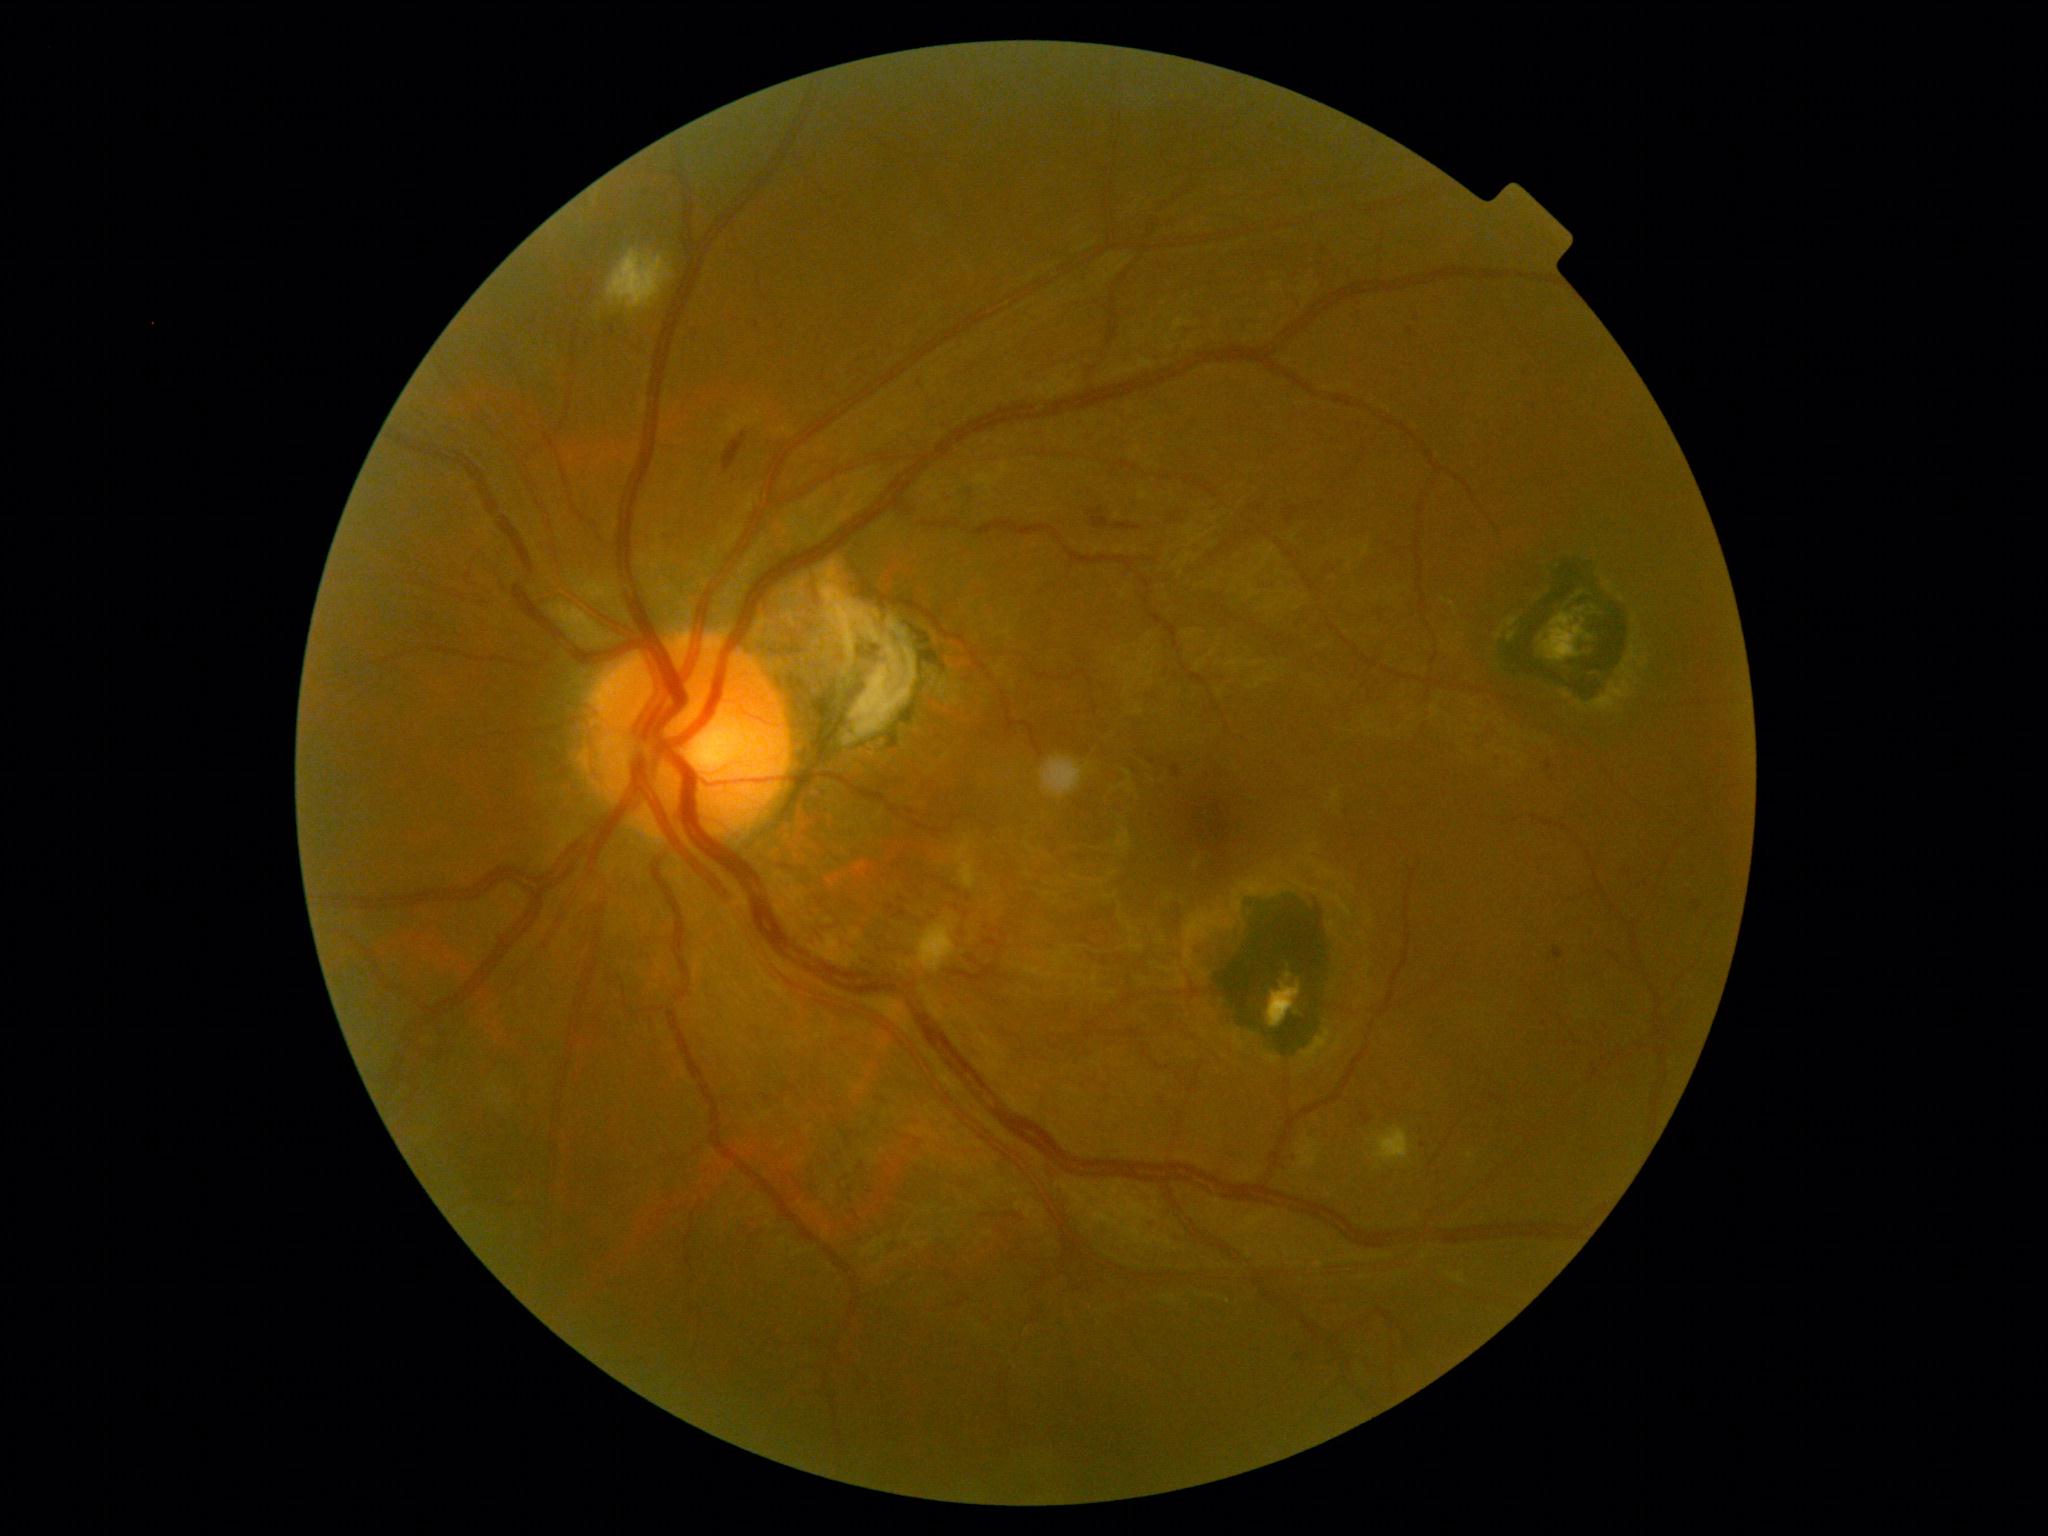
Findings:
• diabetic retinopathy (DR) — moderate NPDR (grade 2)